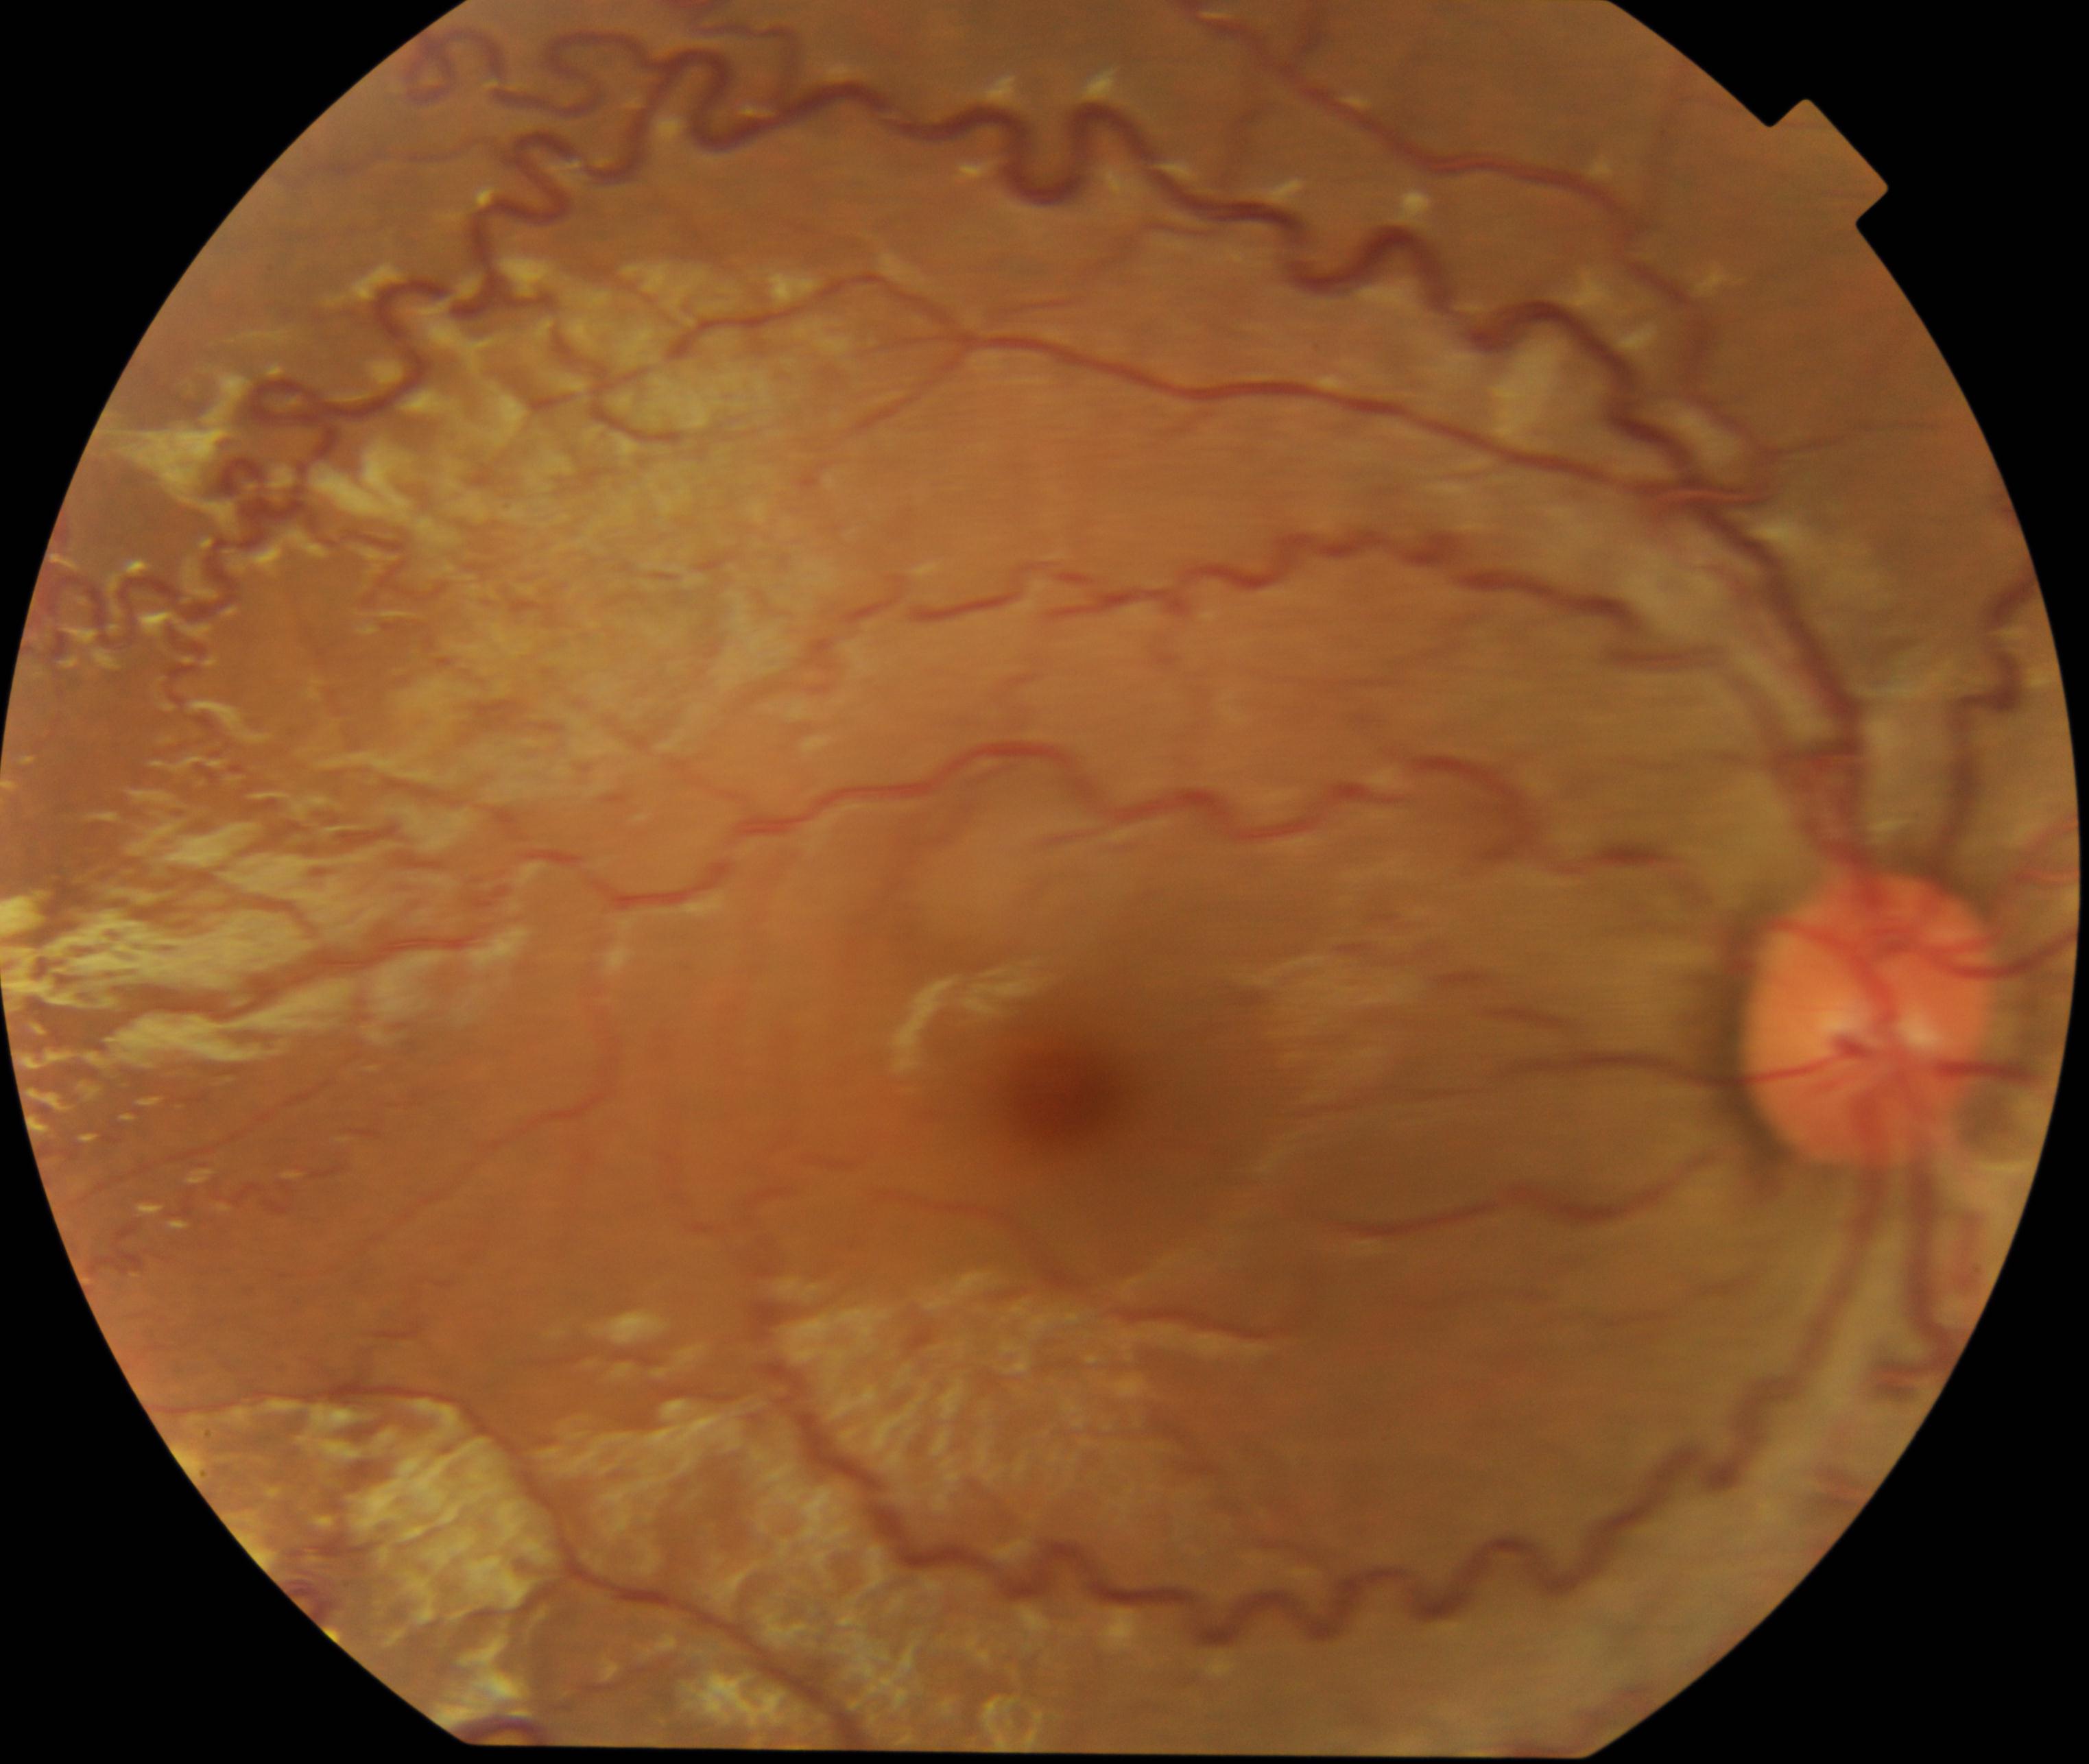 The image shows vessel tortuosity.